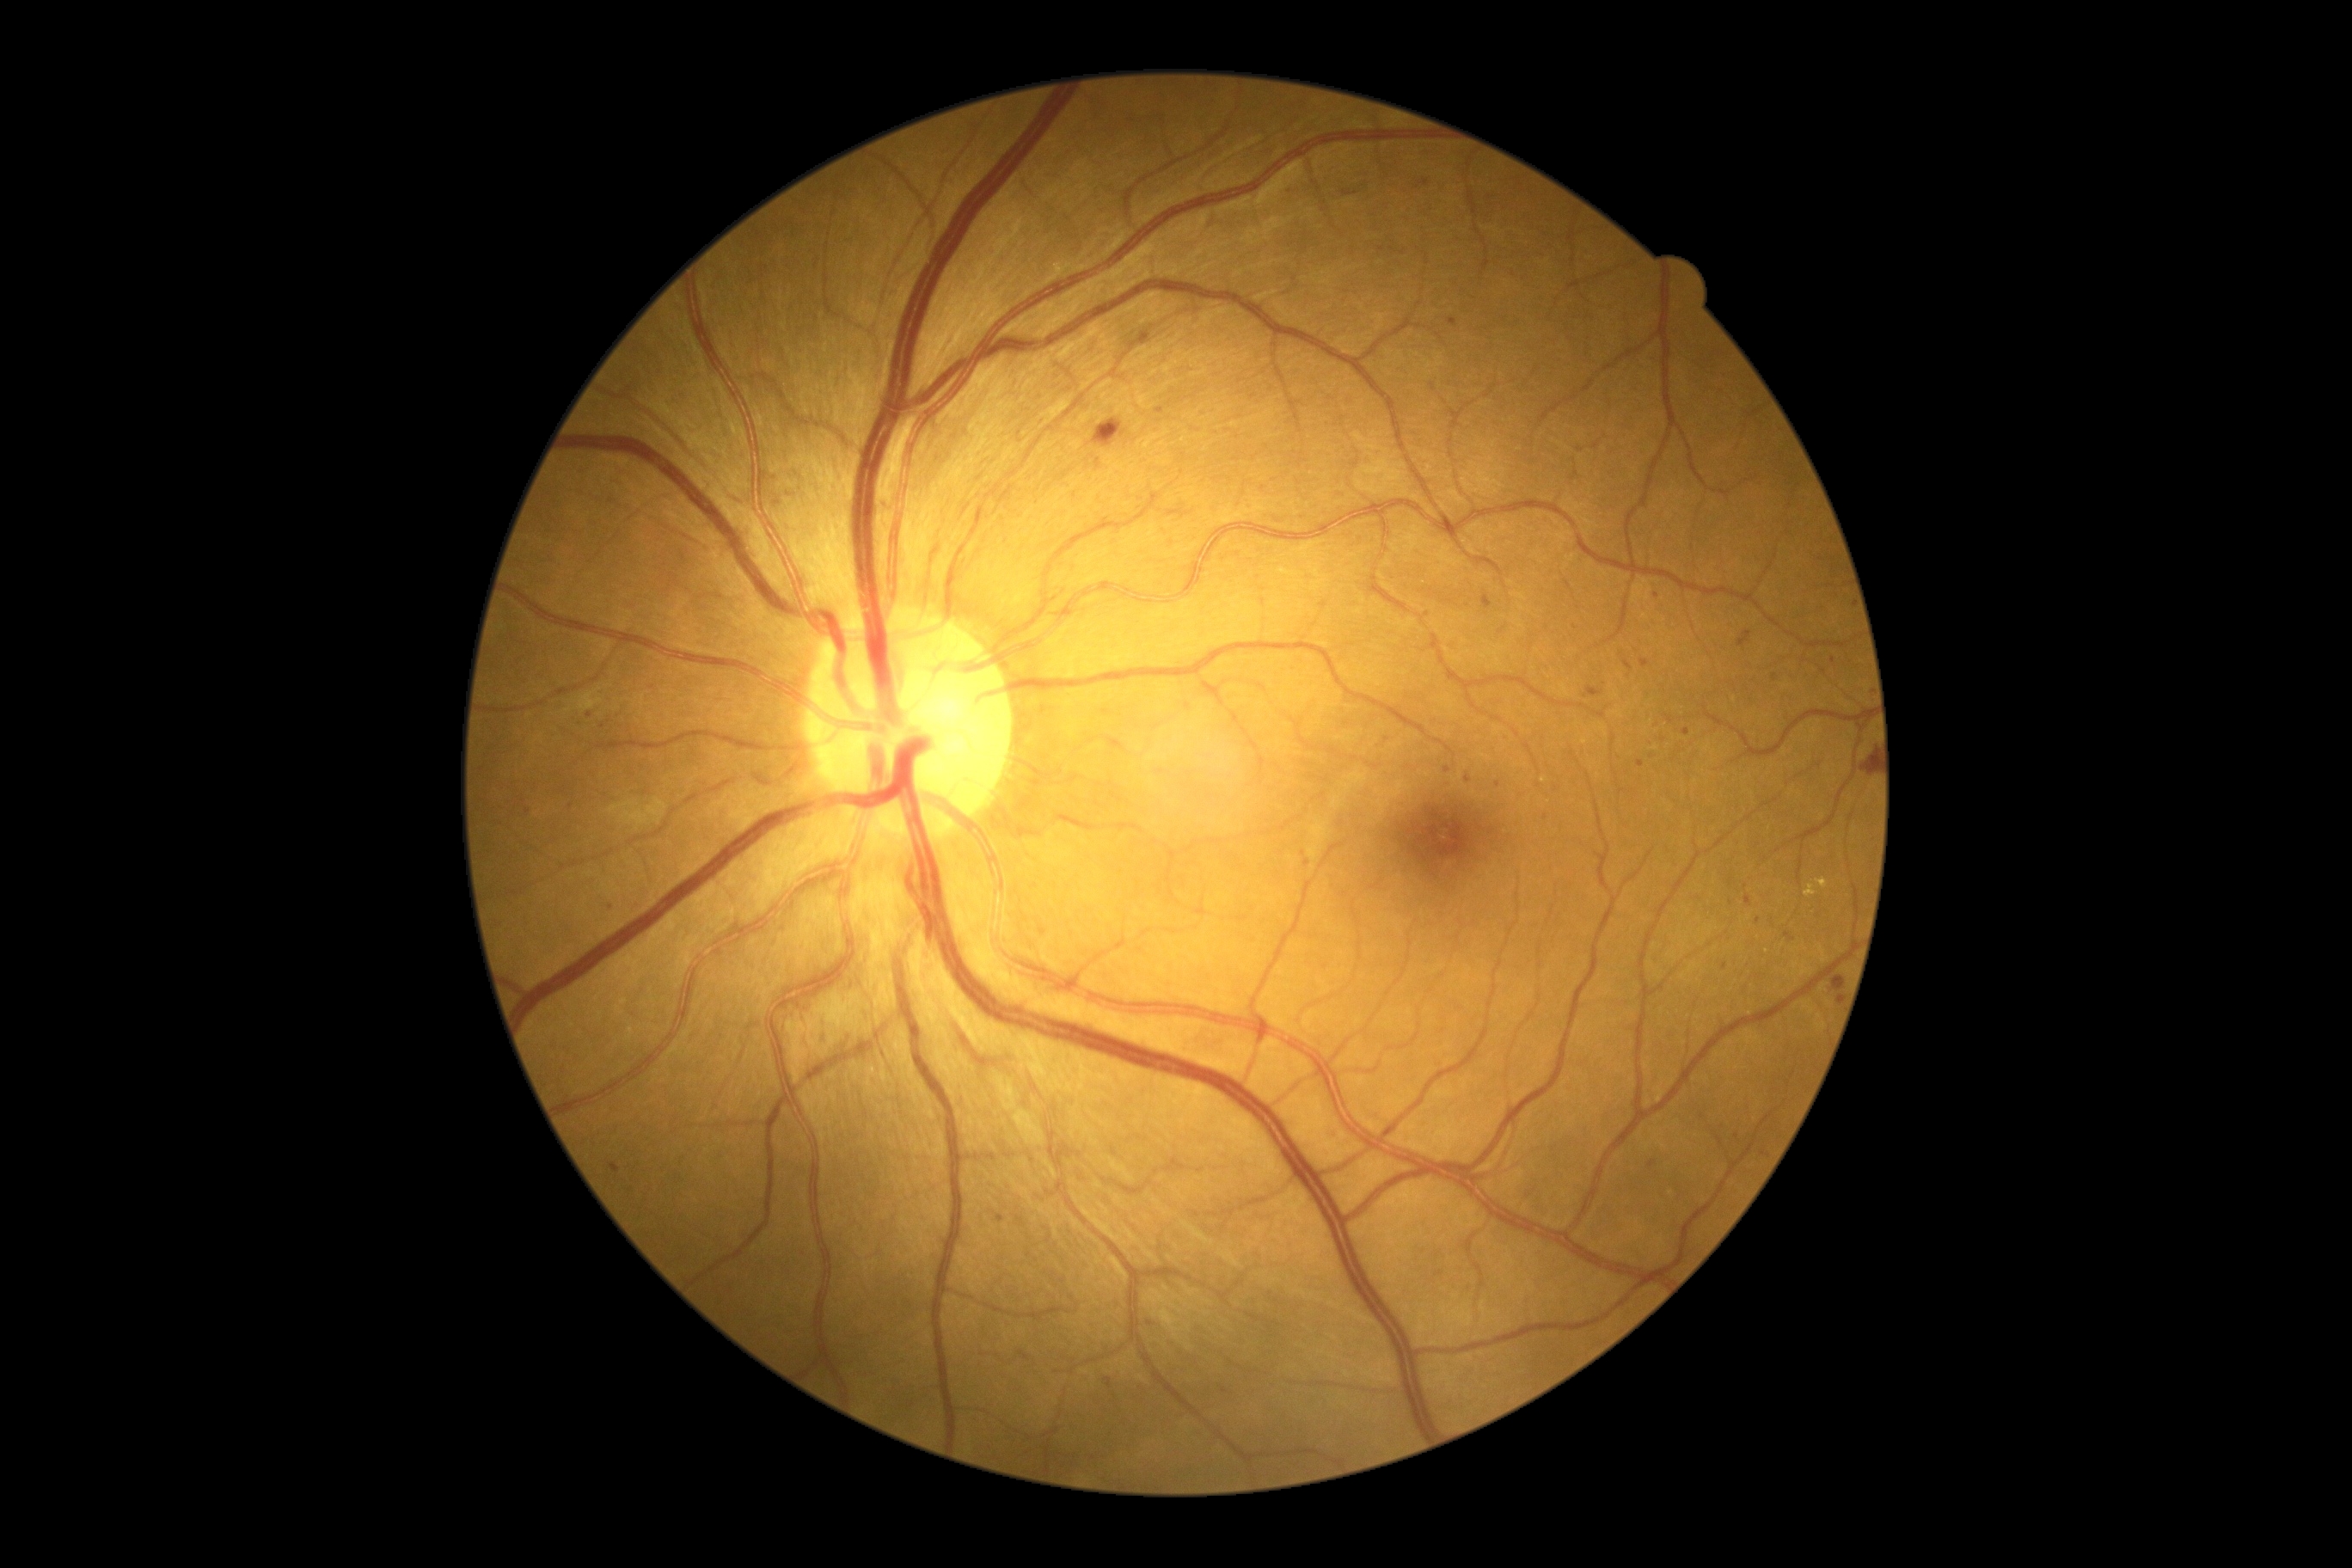

Diabetic retinopathy grade is 2
Representative lesions:
microaneurysms (partial) = (1304, 859, 1313, 867) | (1584, 687, 1605, 699) | (1342, 190, 1359, 197) | (787, 491, 793, 499) | (1744, 895, 1753, 907)
Small microaneurysms near Point(1736, 1136) | Point(571, 807) | Point(1001, 1219) | Point(778, 502) | Point(1347, 724) | Point(1833, 661) | Point(1724, 967) | Point(1641, 764) | Point(603, 727) | Point(1652, 757)